45 degree fundus photograph · nonmydriatic · modified Davis grading · 848x848px:
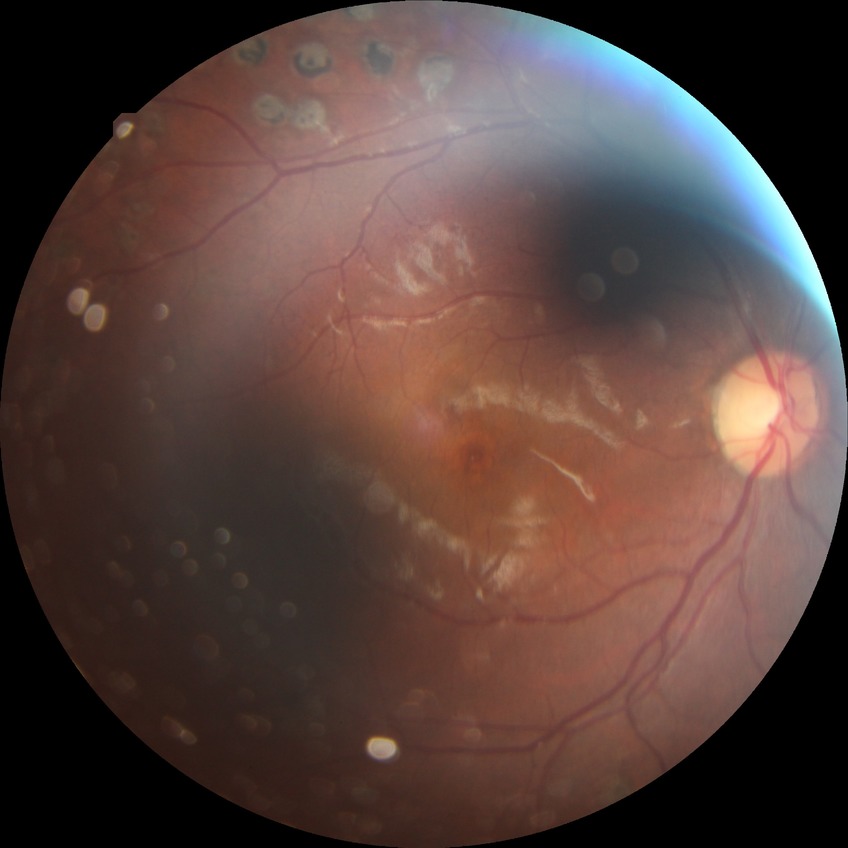

Diabetic retinopathy (DR) is PDR (proliferative diabetic retinopathy).